Field includes the optic disc and macula · Topcon TRC-50DX · 2228x1652px:
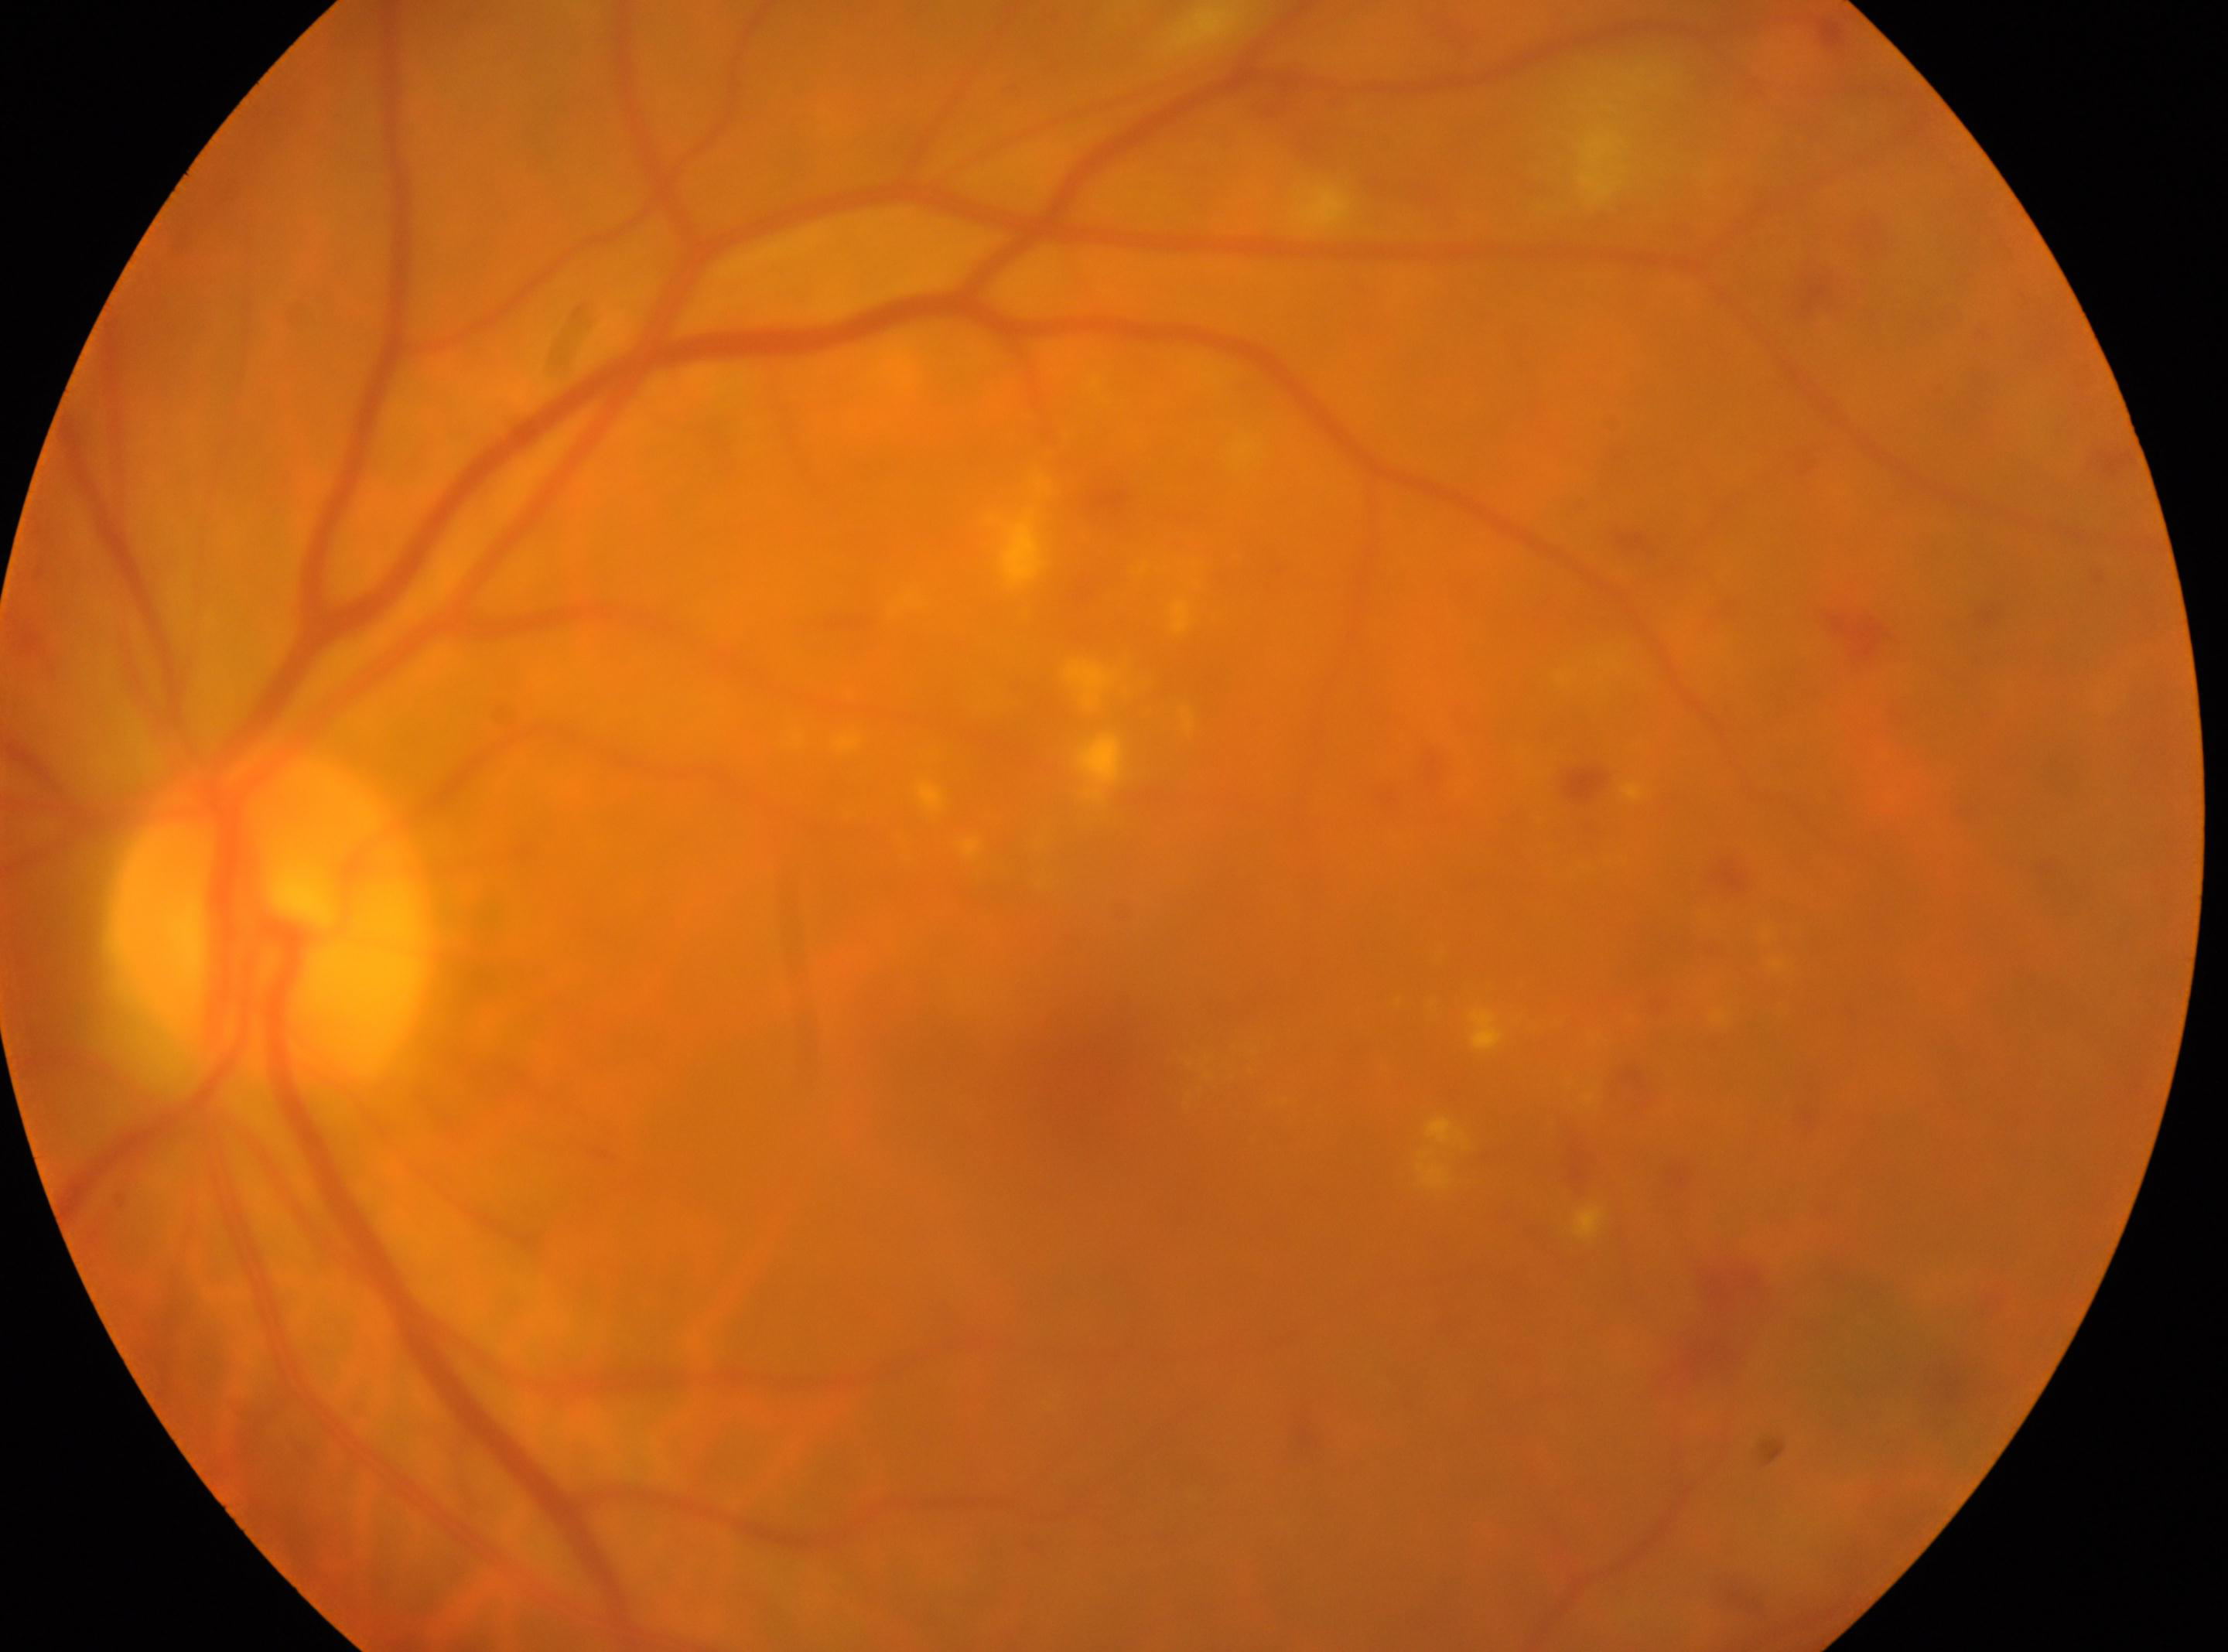
left eye; fovea centralis=(1102, 1083); DR severity=moderate NPDR (grade 2); ONH=(266, 914).